2352 by 1568 pixels
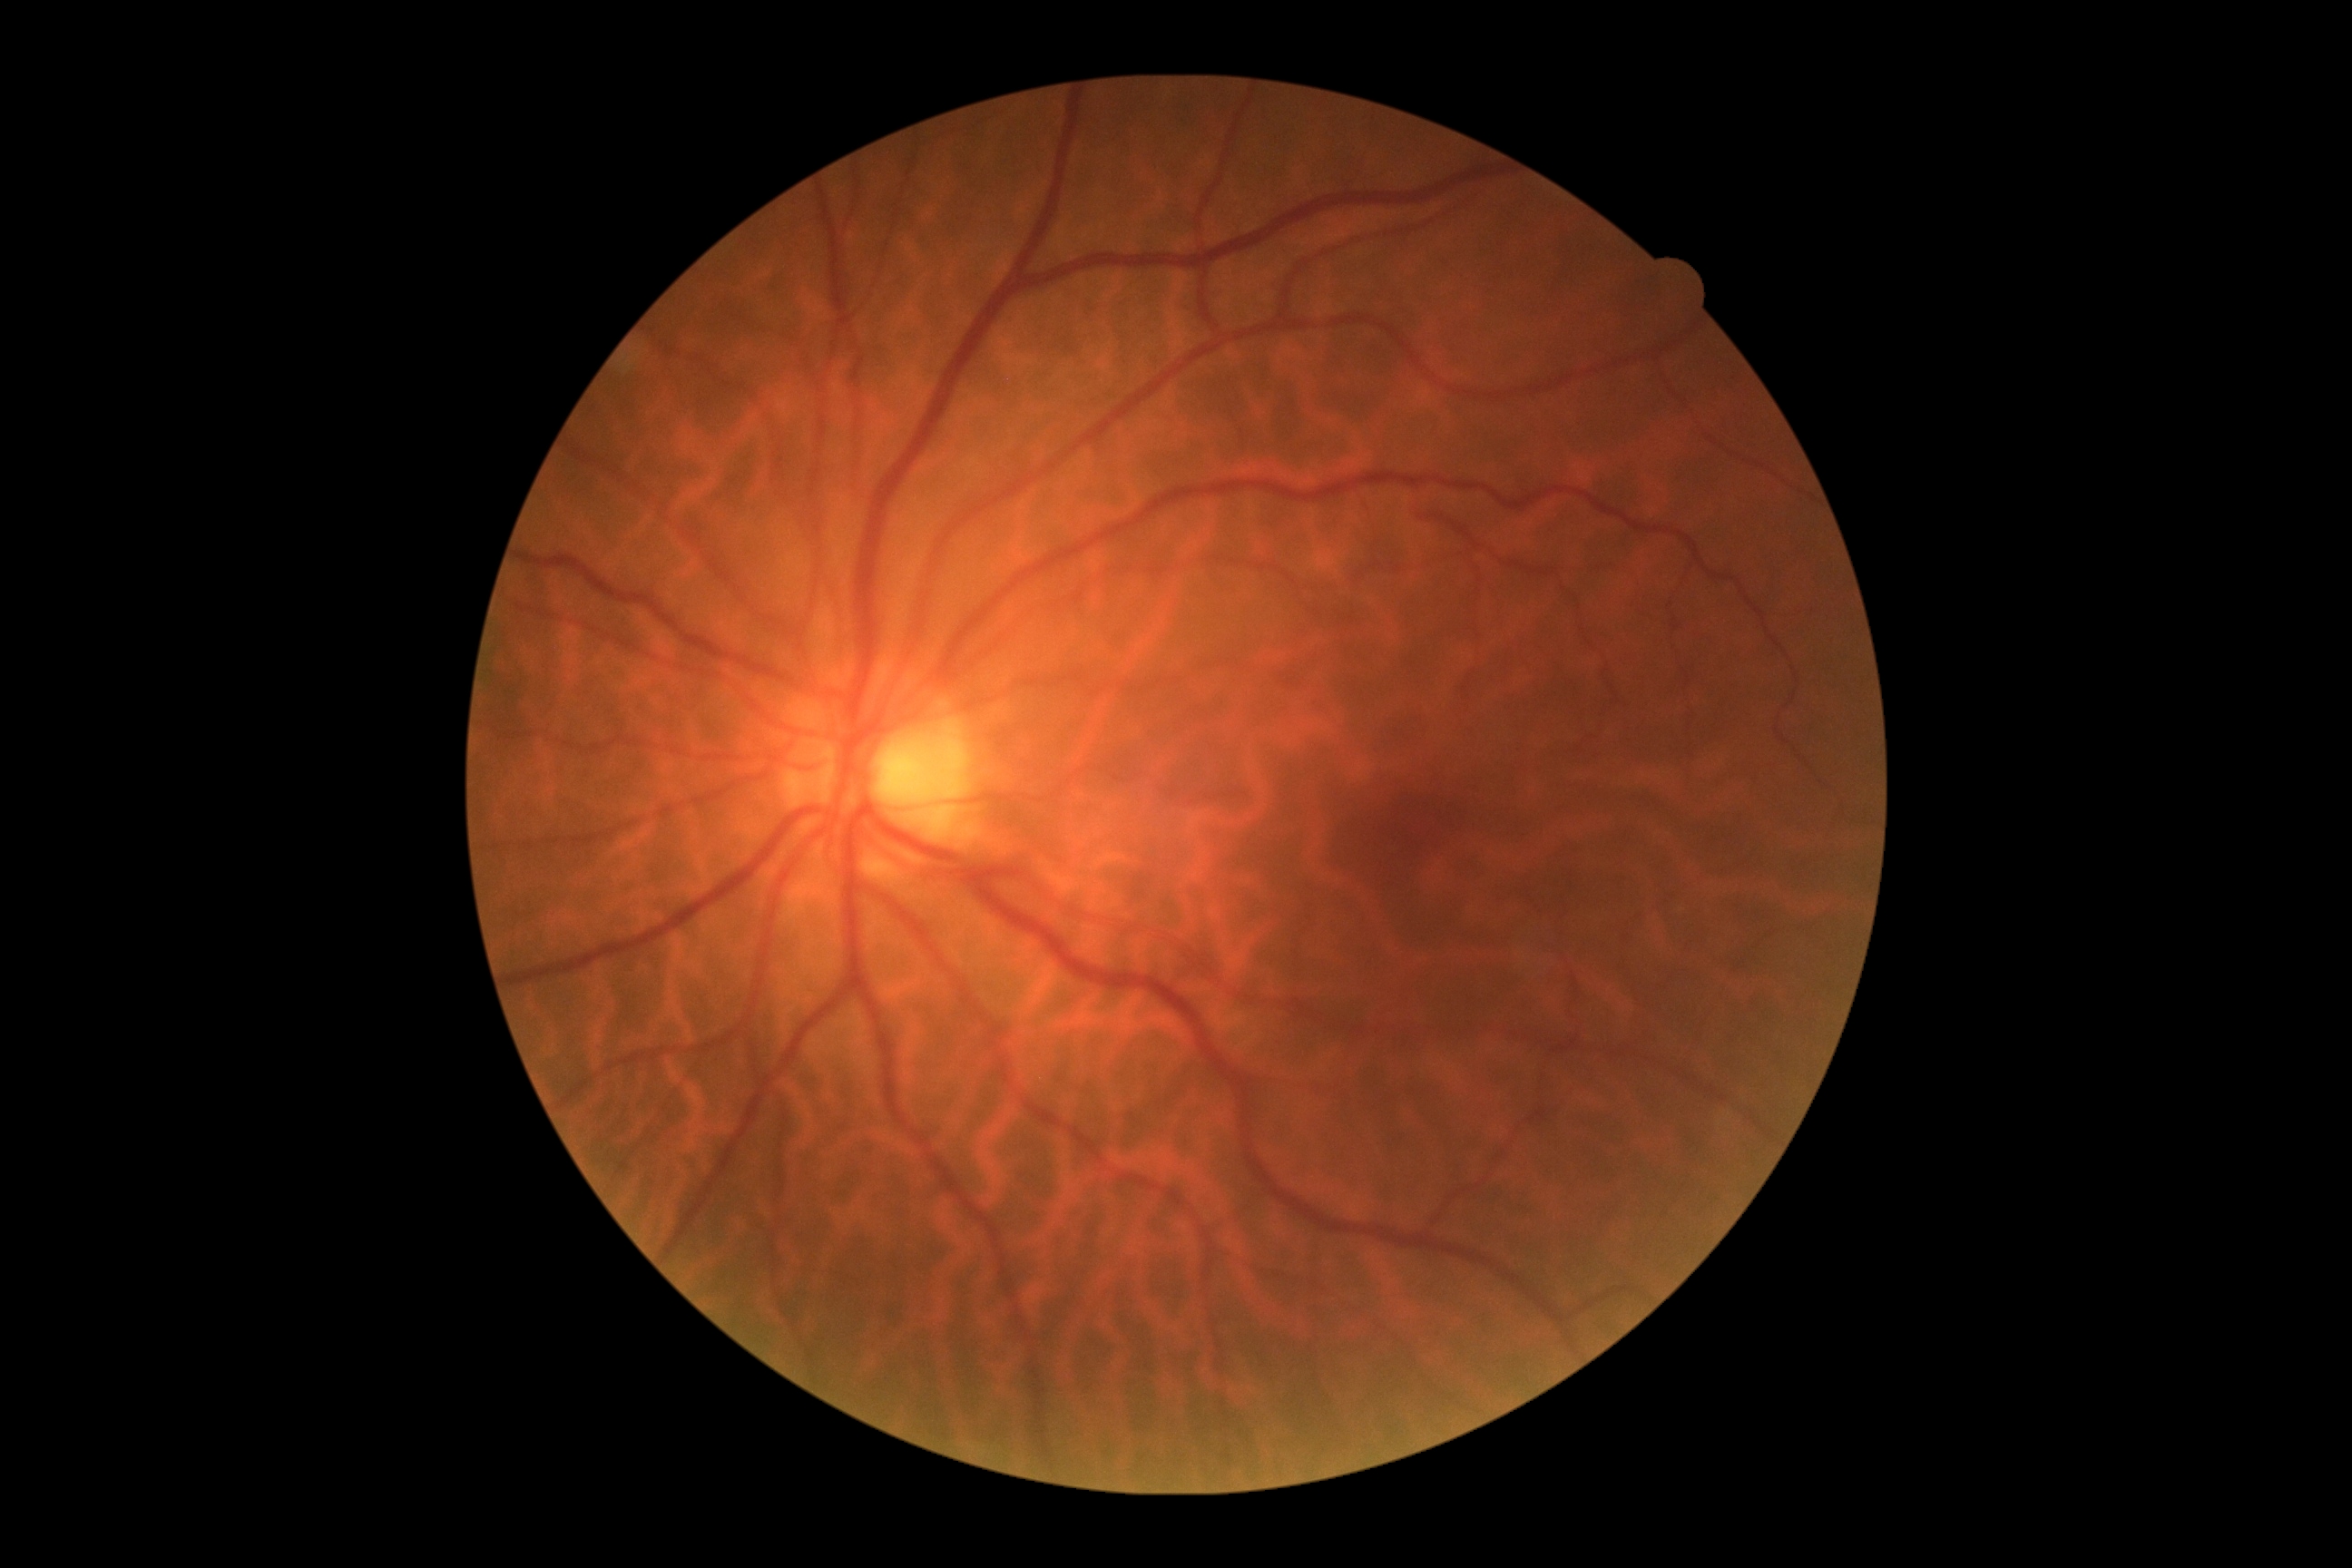
Diabetic retinopathy severity is 0/4 — no visible signs of diabetic retinopathy.
No apparent diabetic retinopathy.